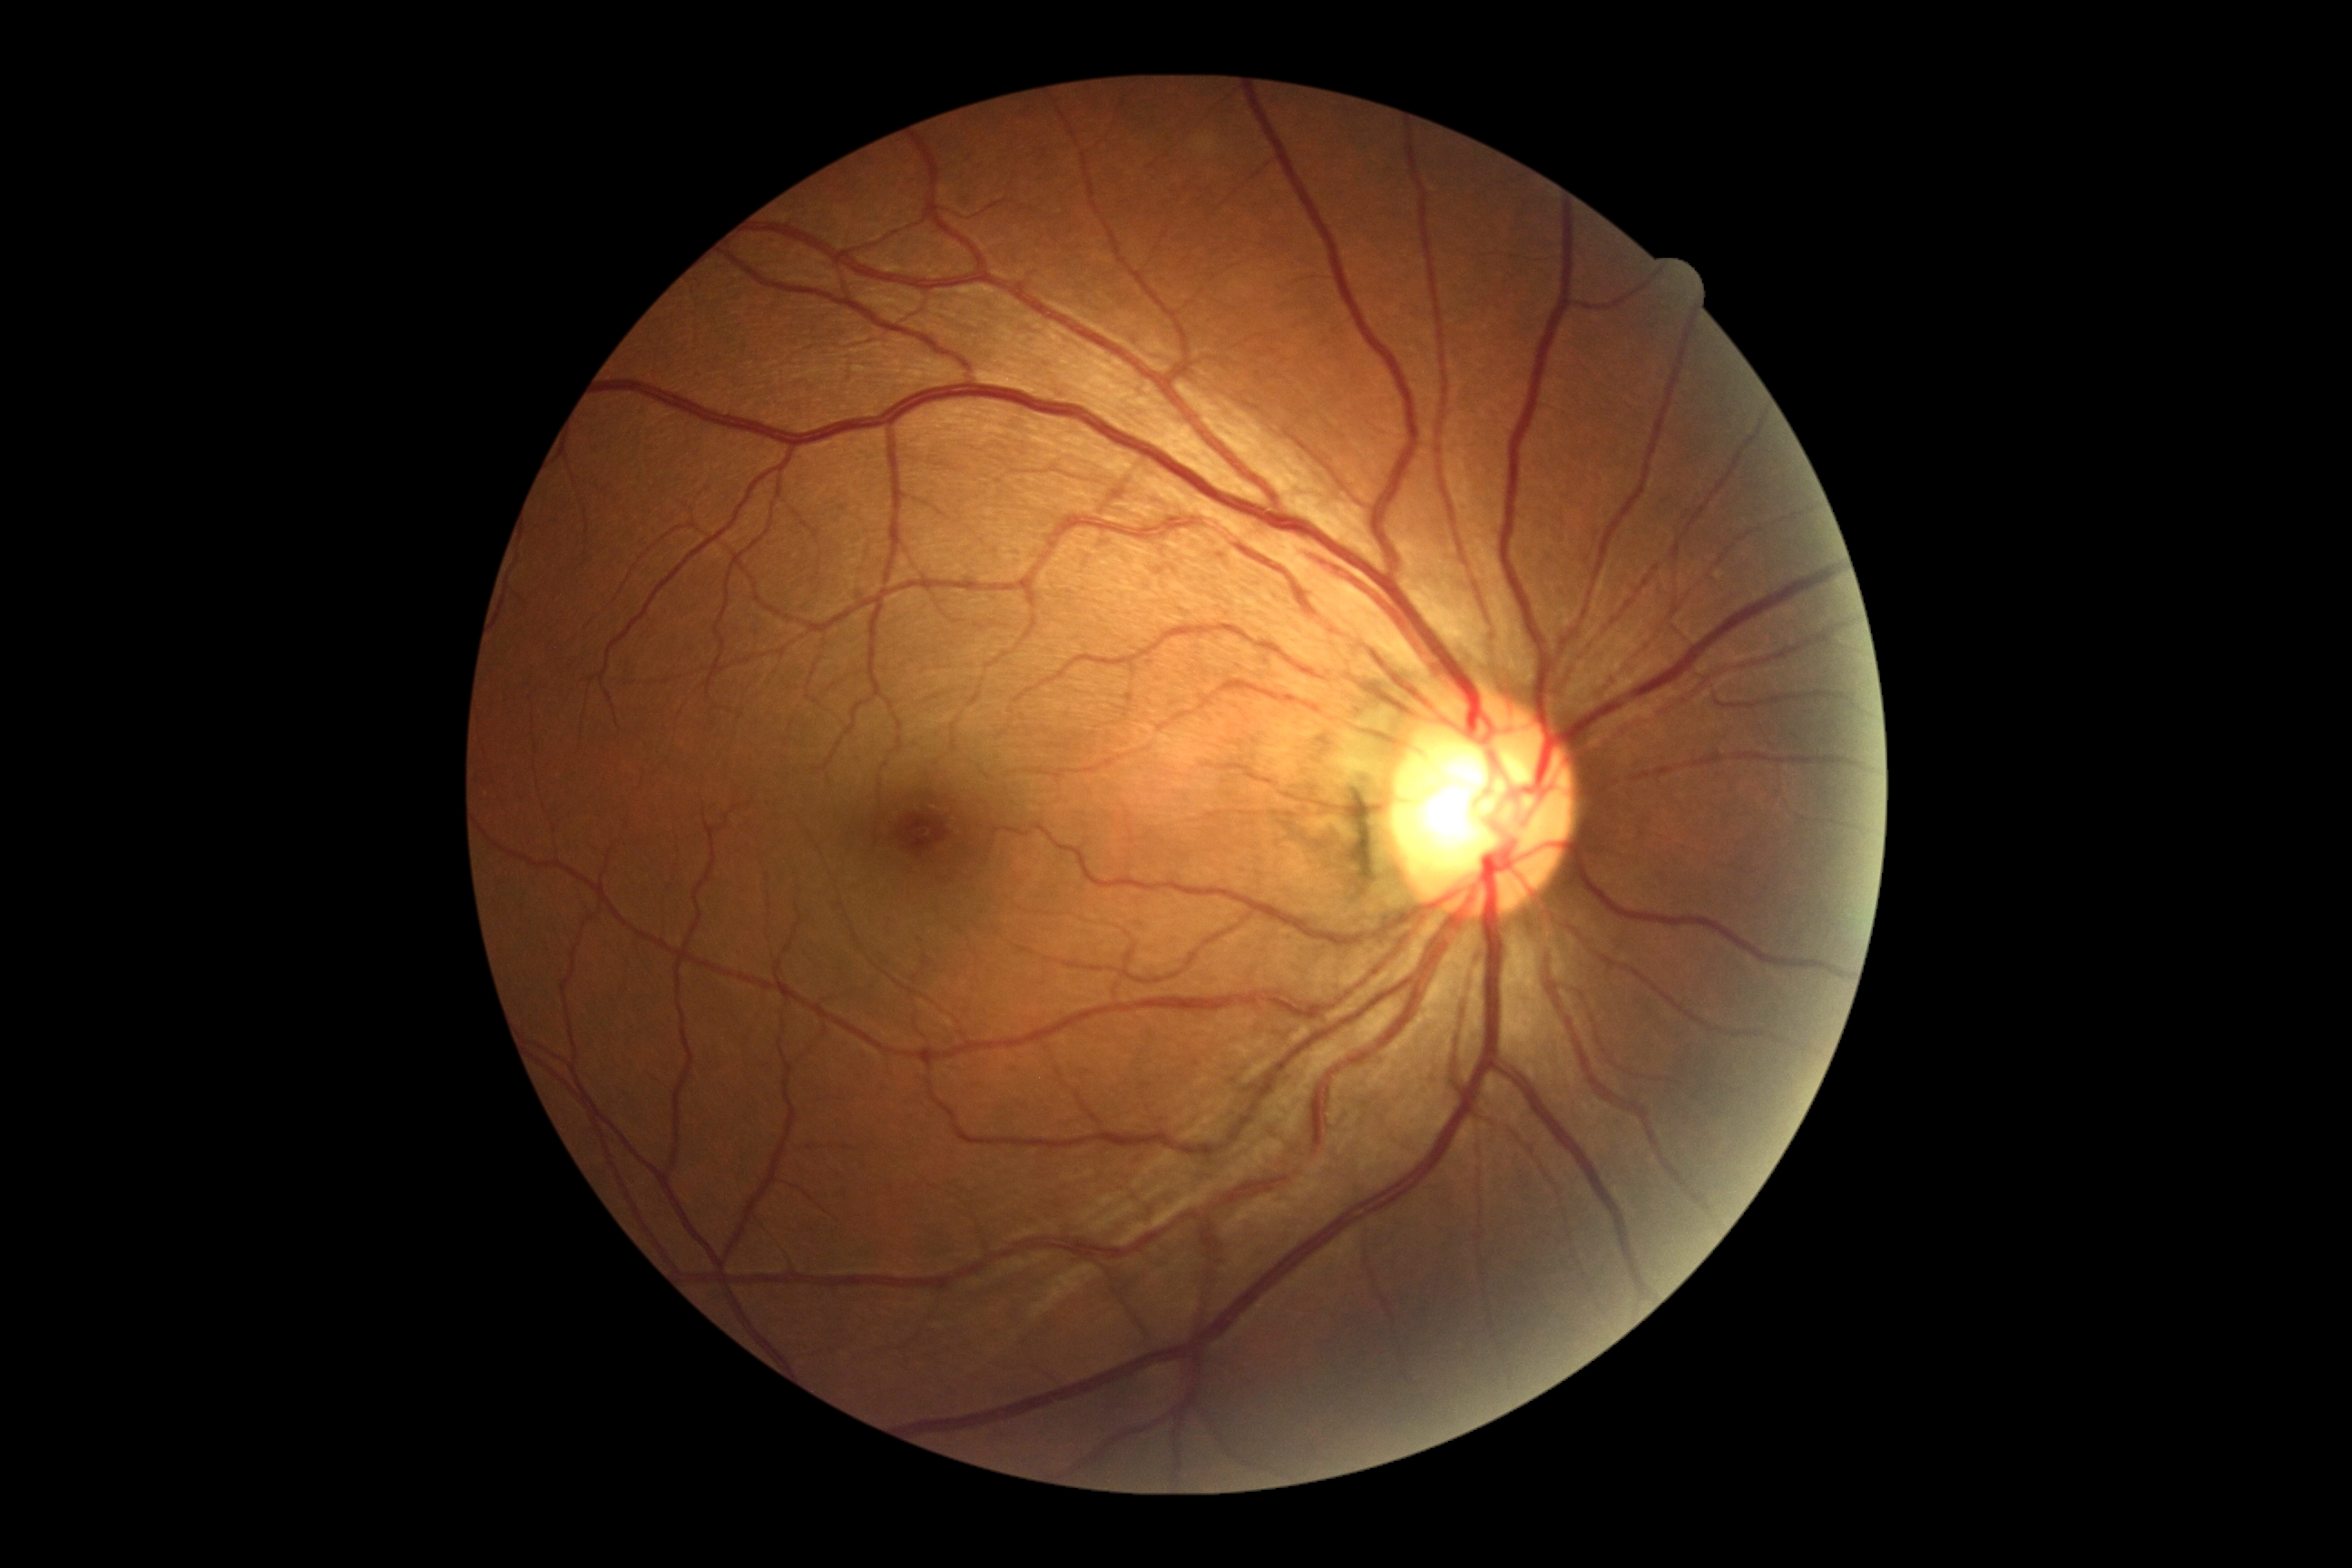 Diabetic retinopathy (DR): 0/4.